Fundus photo:
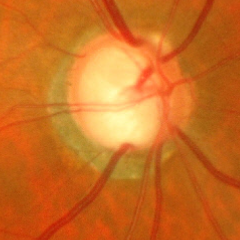

Findings consistent with glaucoma. Impression = advanced glaucoma.